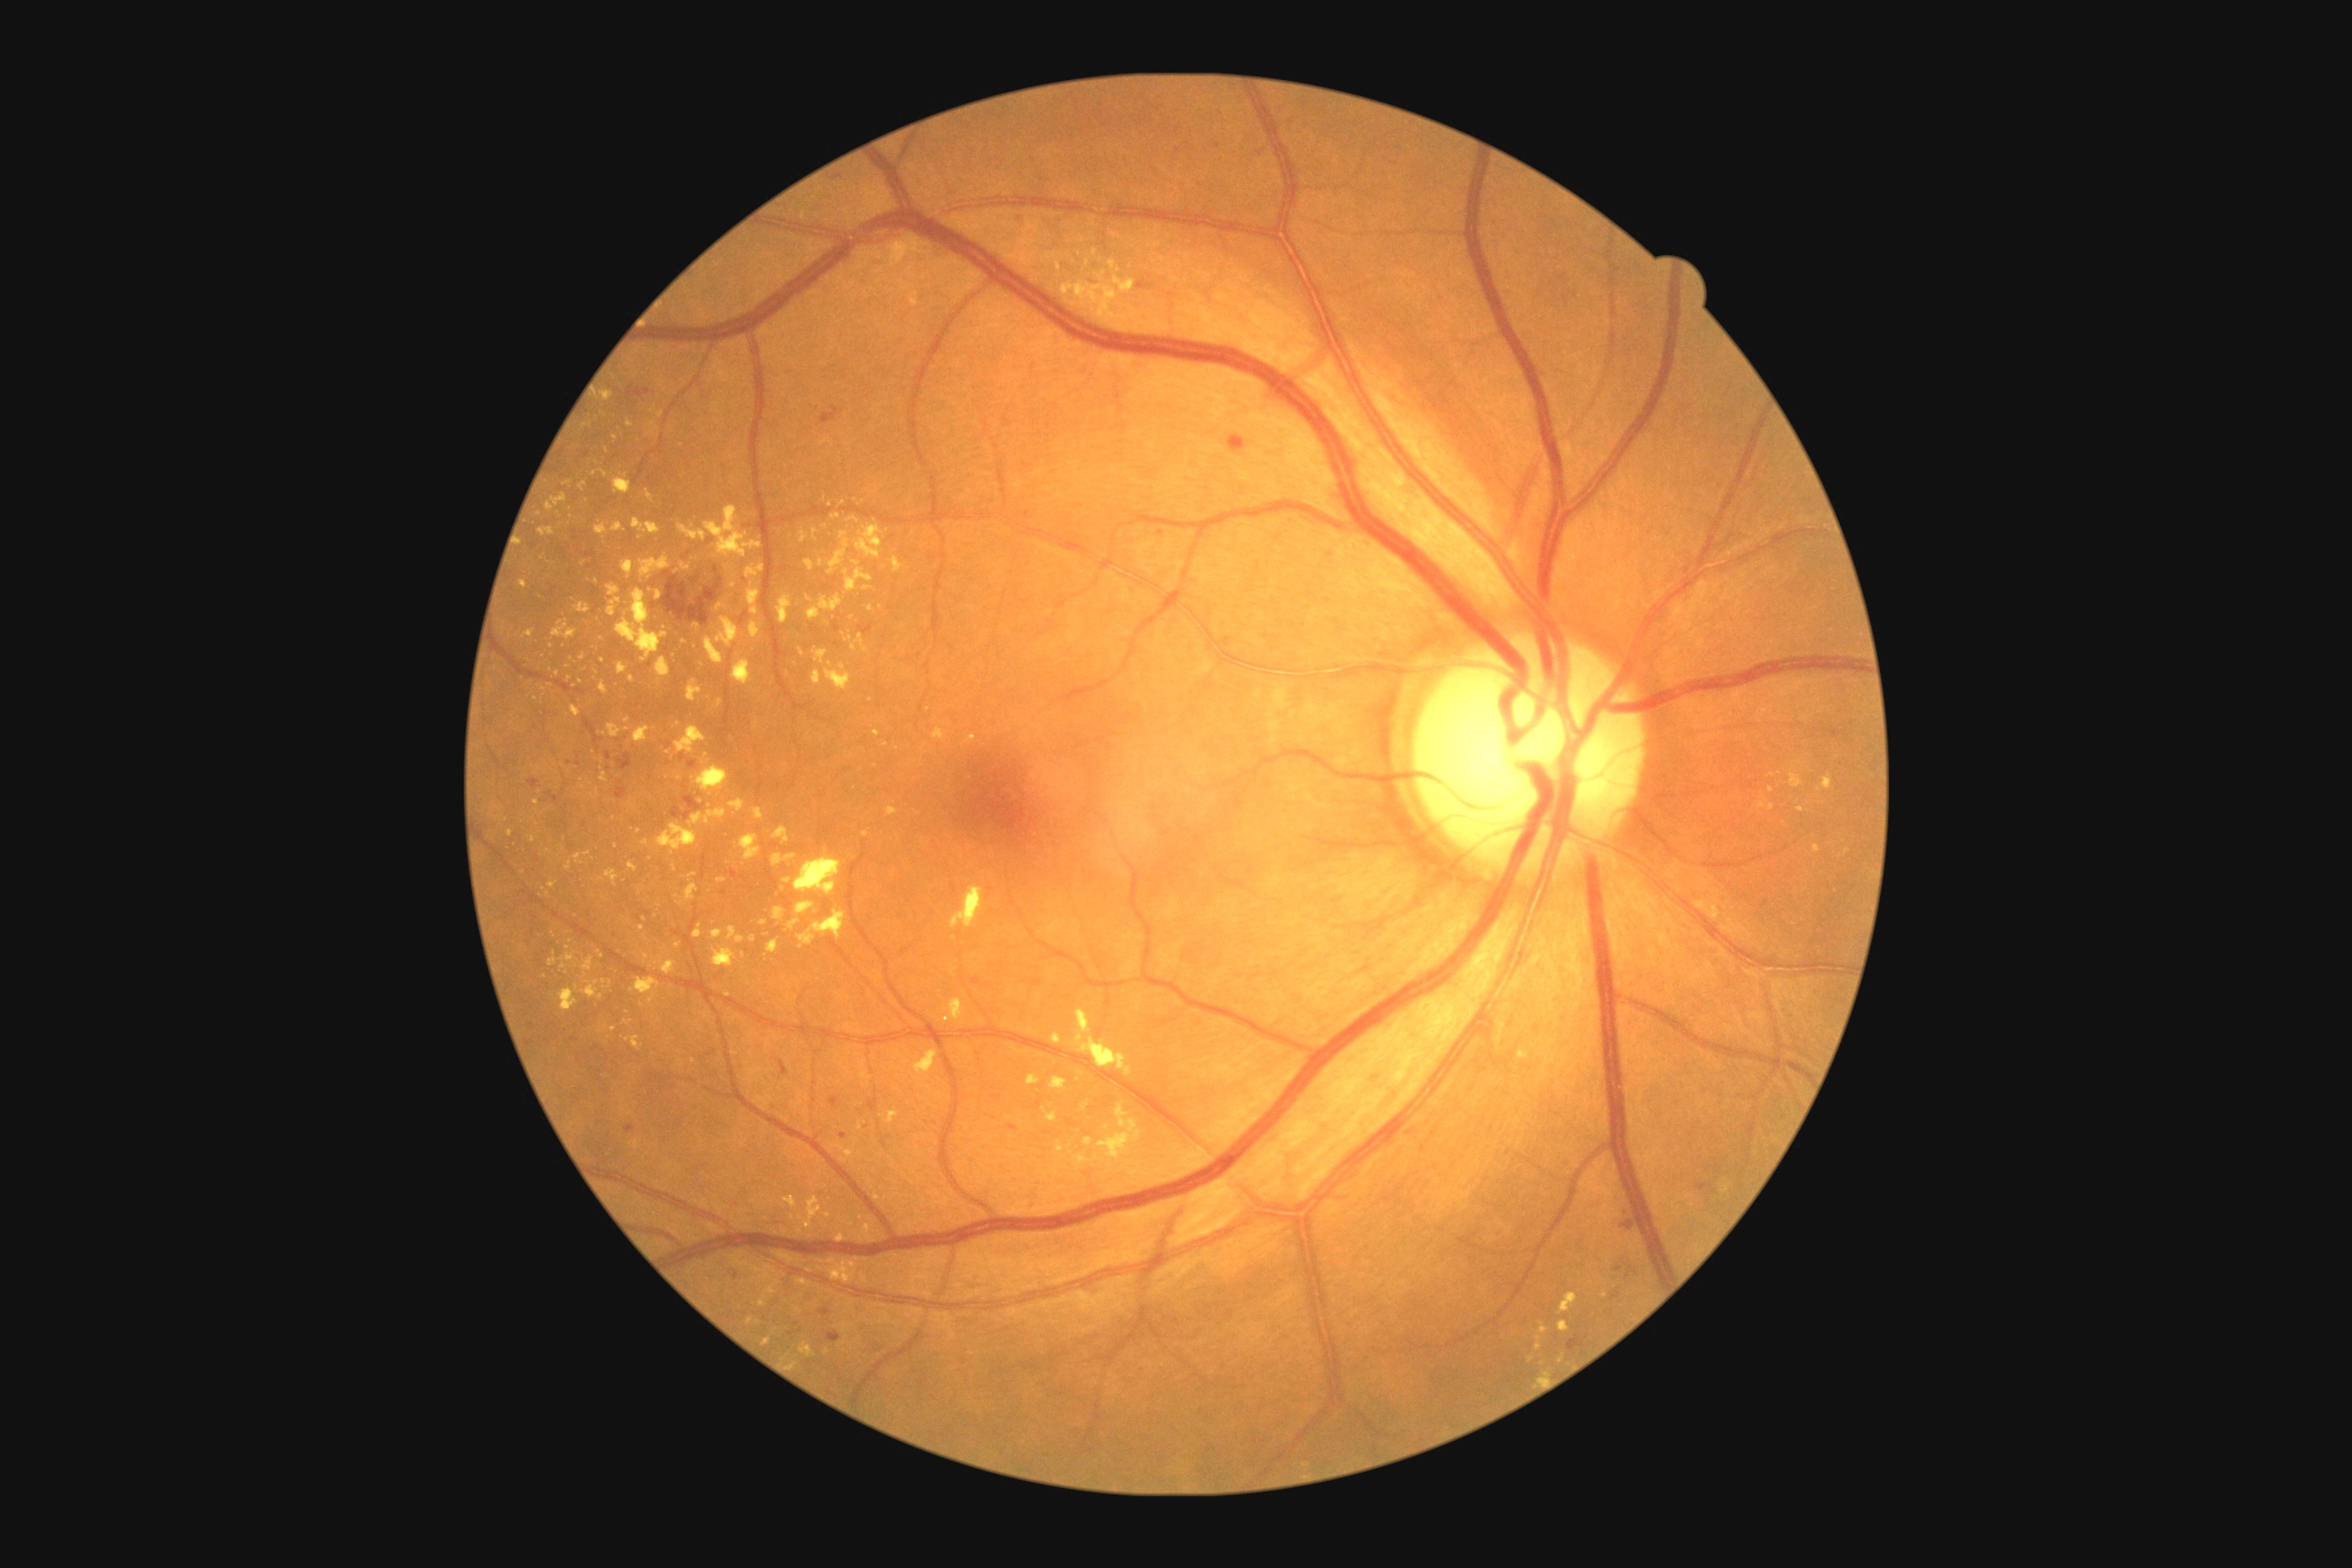

Retinopathy is grade 2 — more than just microaneurysms but less than severe NPDR.
Hard exudates include those at 634, 727, 651, 743 | 754, 721, 760, 730 | 825, 669, 852, 691 | 747, 589, 761, 616 | 605, 870, 618, 887 | 798, 1279, 810, 1286 | 798, 910, 847, 950 | 549, 952, 558, 968 | 627, 420, 634, 429 | 730, 583, 738, 589 | 836, 1233, 847, 1244.
Smaller hard exudates around 794/1217 | 580/682 | 1107/1128 | 652/425 | 614/819 | 869/1219 | 955/939 | 549/894.